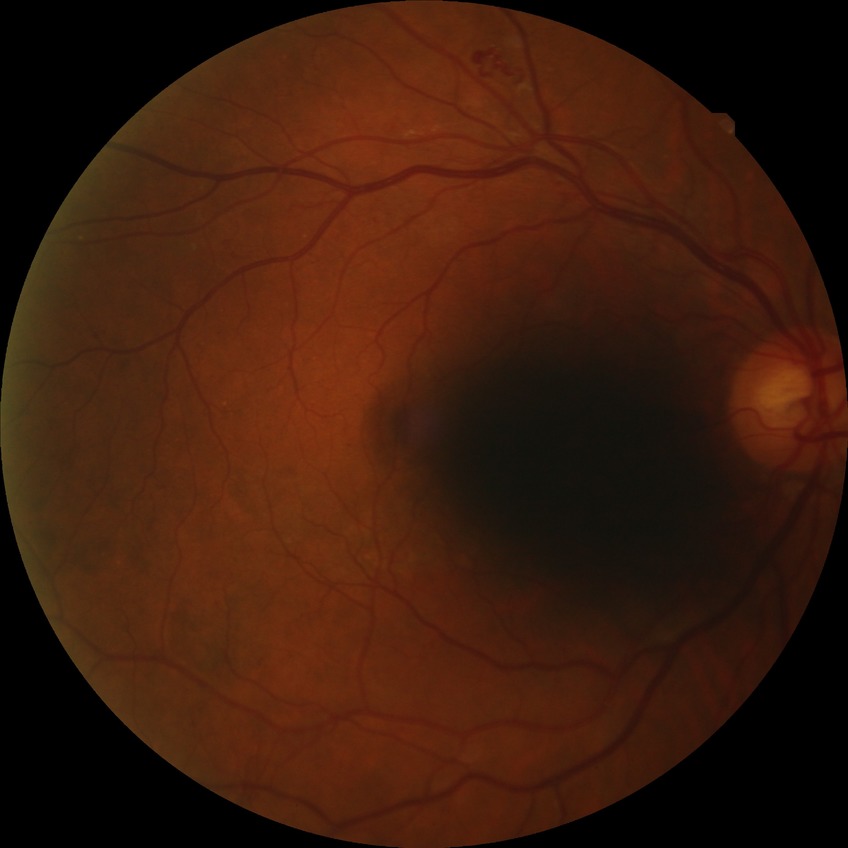

Retinopathy grade: proliferative diabetic retinopathy.